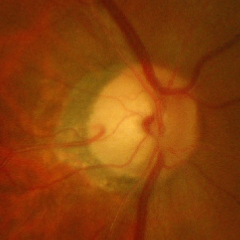

Advanced glaucomatous optic neuropathy.